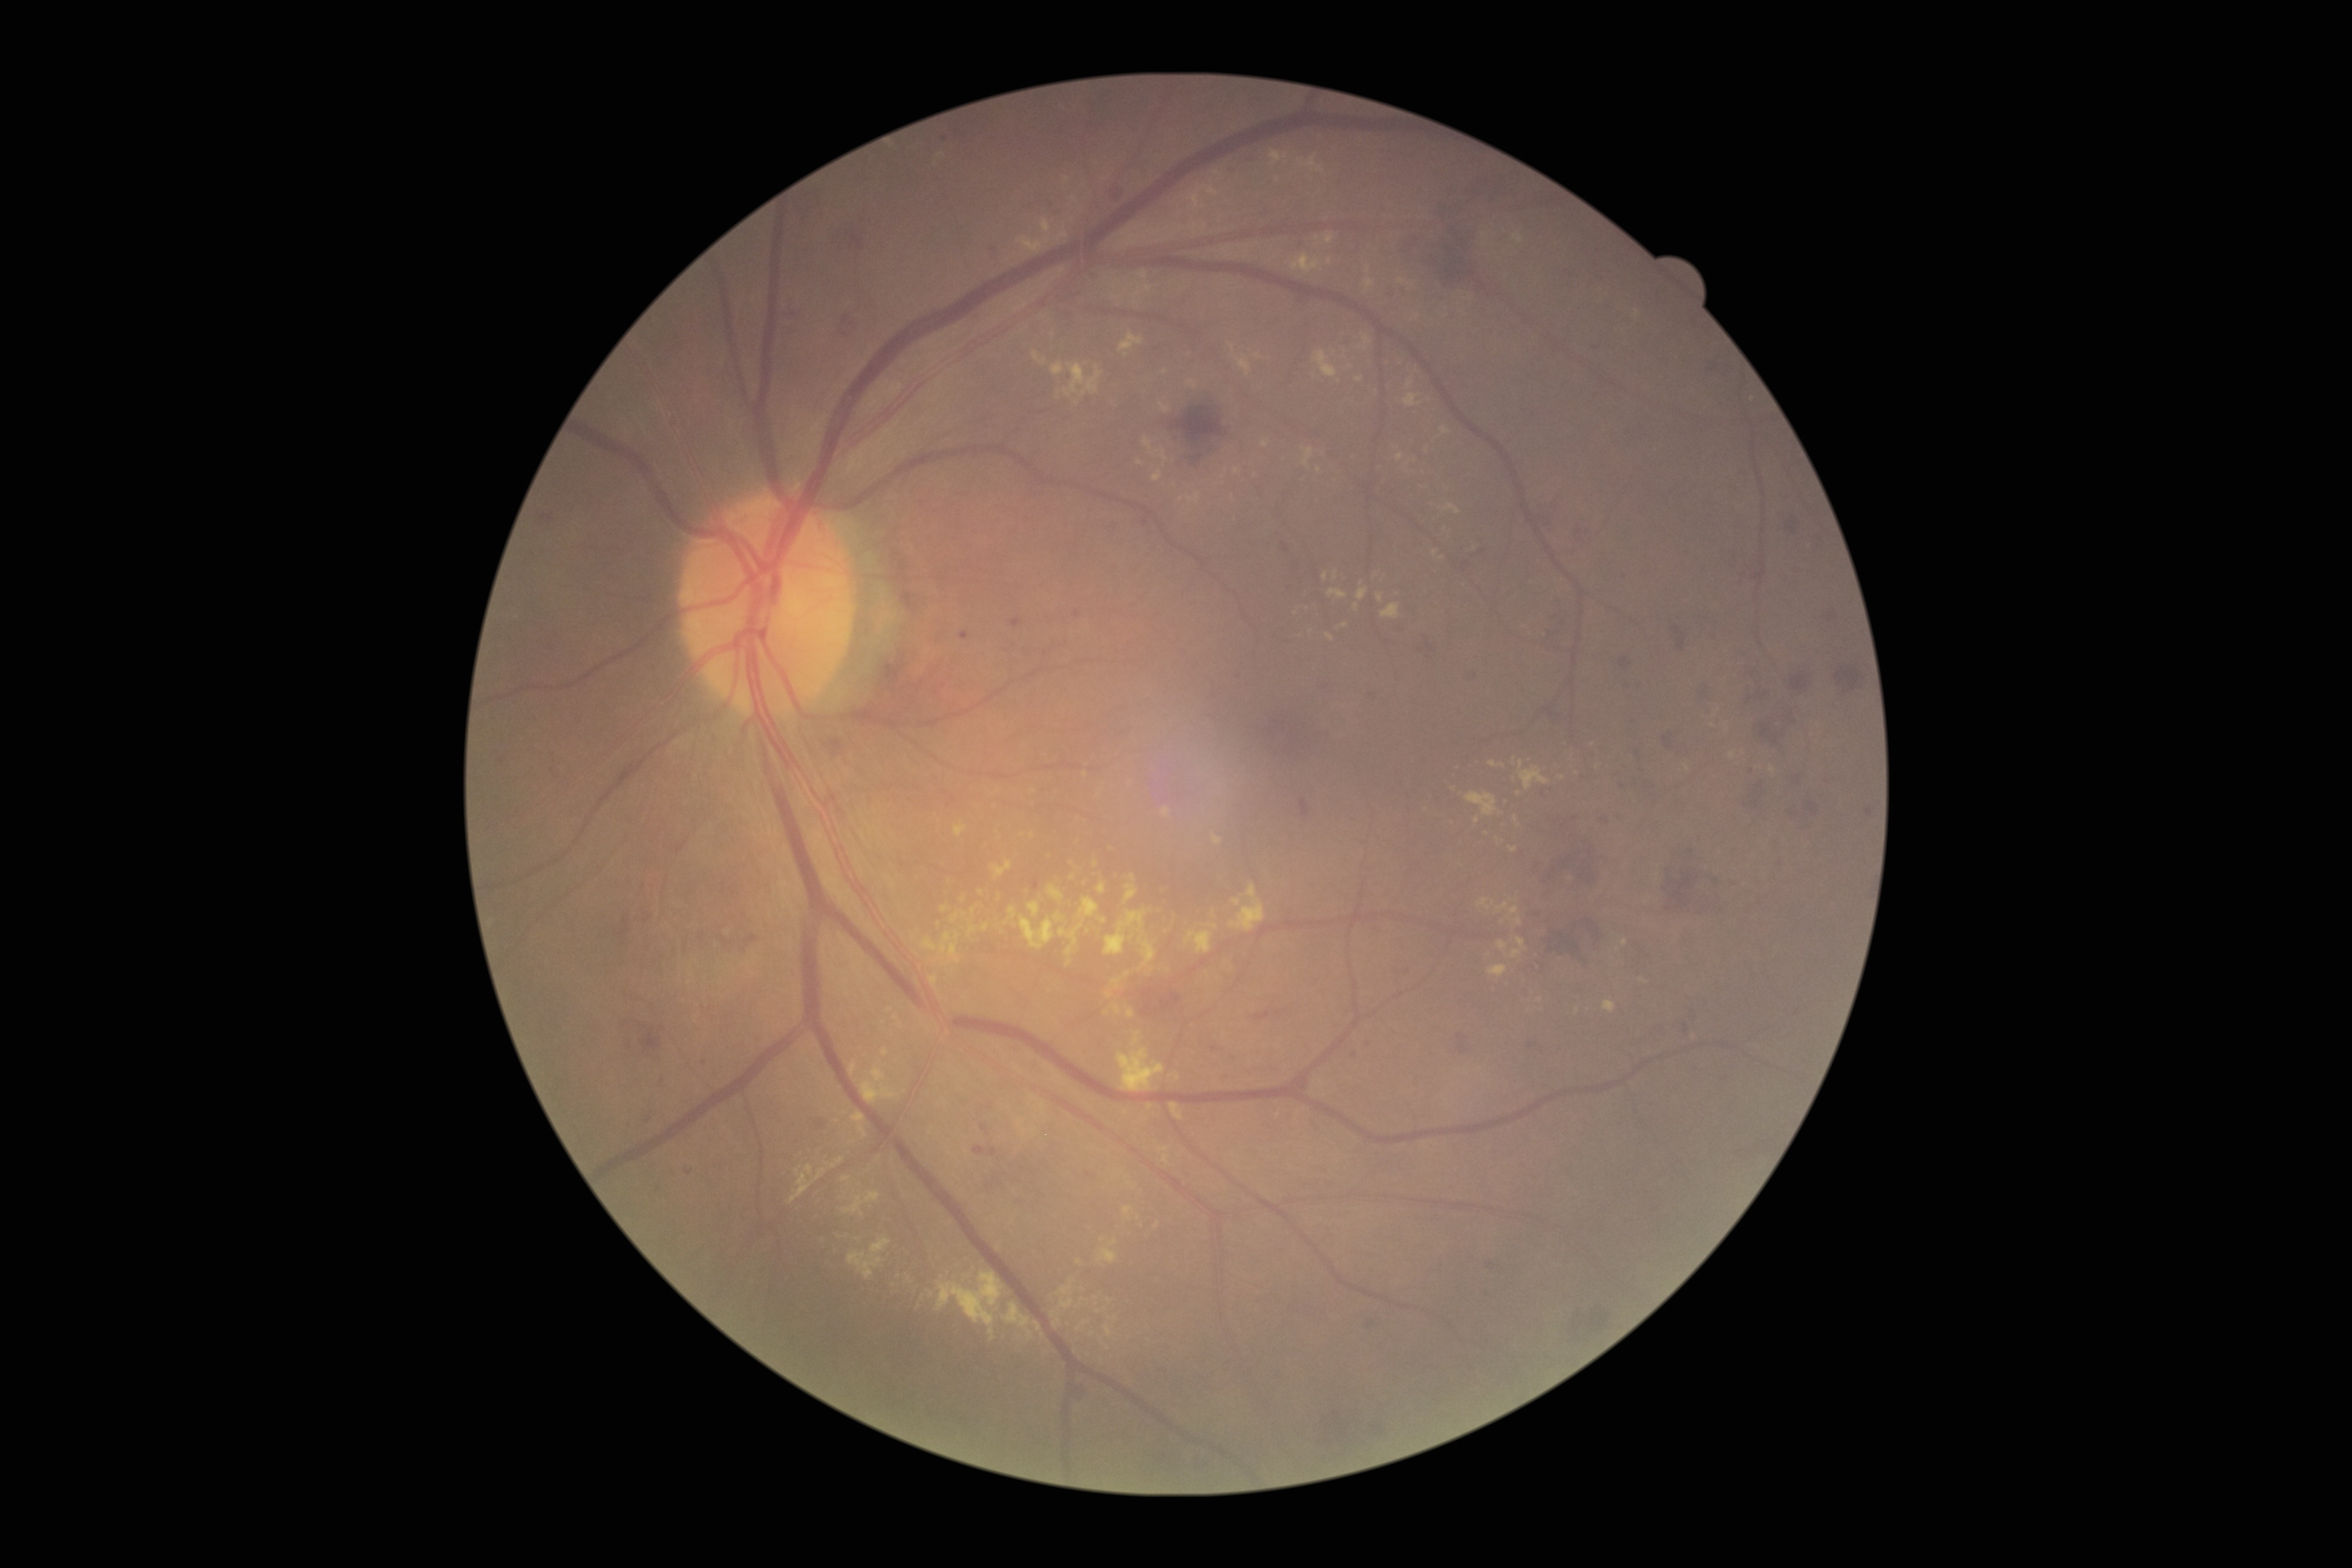

Diabetic retinopathy severity is 2
Selected lesions:
hard exudates (more not shown) = 1269:151:1287:166; 1769:766:1777:775; 1120:332:1144:353; 1208:924:1219:931; 952:913:960:924; 849:1237:891:1278; 1152:470:1162:482; 1100:918:1108:924; 1230:344:1253:378; 1103:1324:1114:1338; 1328:590:1347:599
Small hard exudates approximately at {"x": 1068, "y": 963}; {"x": 1417, "y": 316}; {"x": 1401, "y": 281}; {"x": 1319, "y": 471}; {"x": 1277, "y": 1115}; {"x": 1079, "y": 1261}; {"x": 1643, "y": 980}; {"x": 1442, "y": 558}
hemorrhages (more not shown) = 1526:1040:1534:1048; 1368:688:1379:699; 1696:683:1710:700; 1572:515:1587:534; 1774:511:1801:532; 1865:806:1873:816; 973:1146:987:1156; 1598:811:1612:821; 1171:406:1224:449; 1254:1011:1271:1023; 1544:500:1558:529; 1486:1258:1501:1269; 1740:779:1772:815; 1195:453:1207:471; 1300:799:1310:816; 1727:875:1740:883
Small hemorrhages approximately at {"x": 1421, "y": 650}